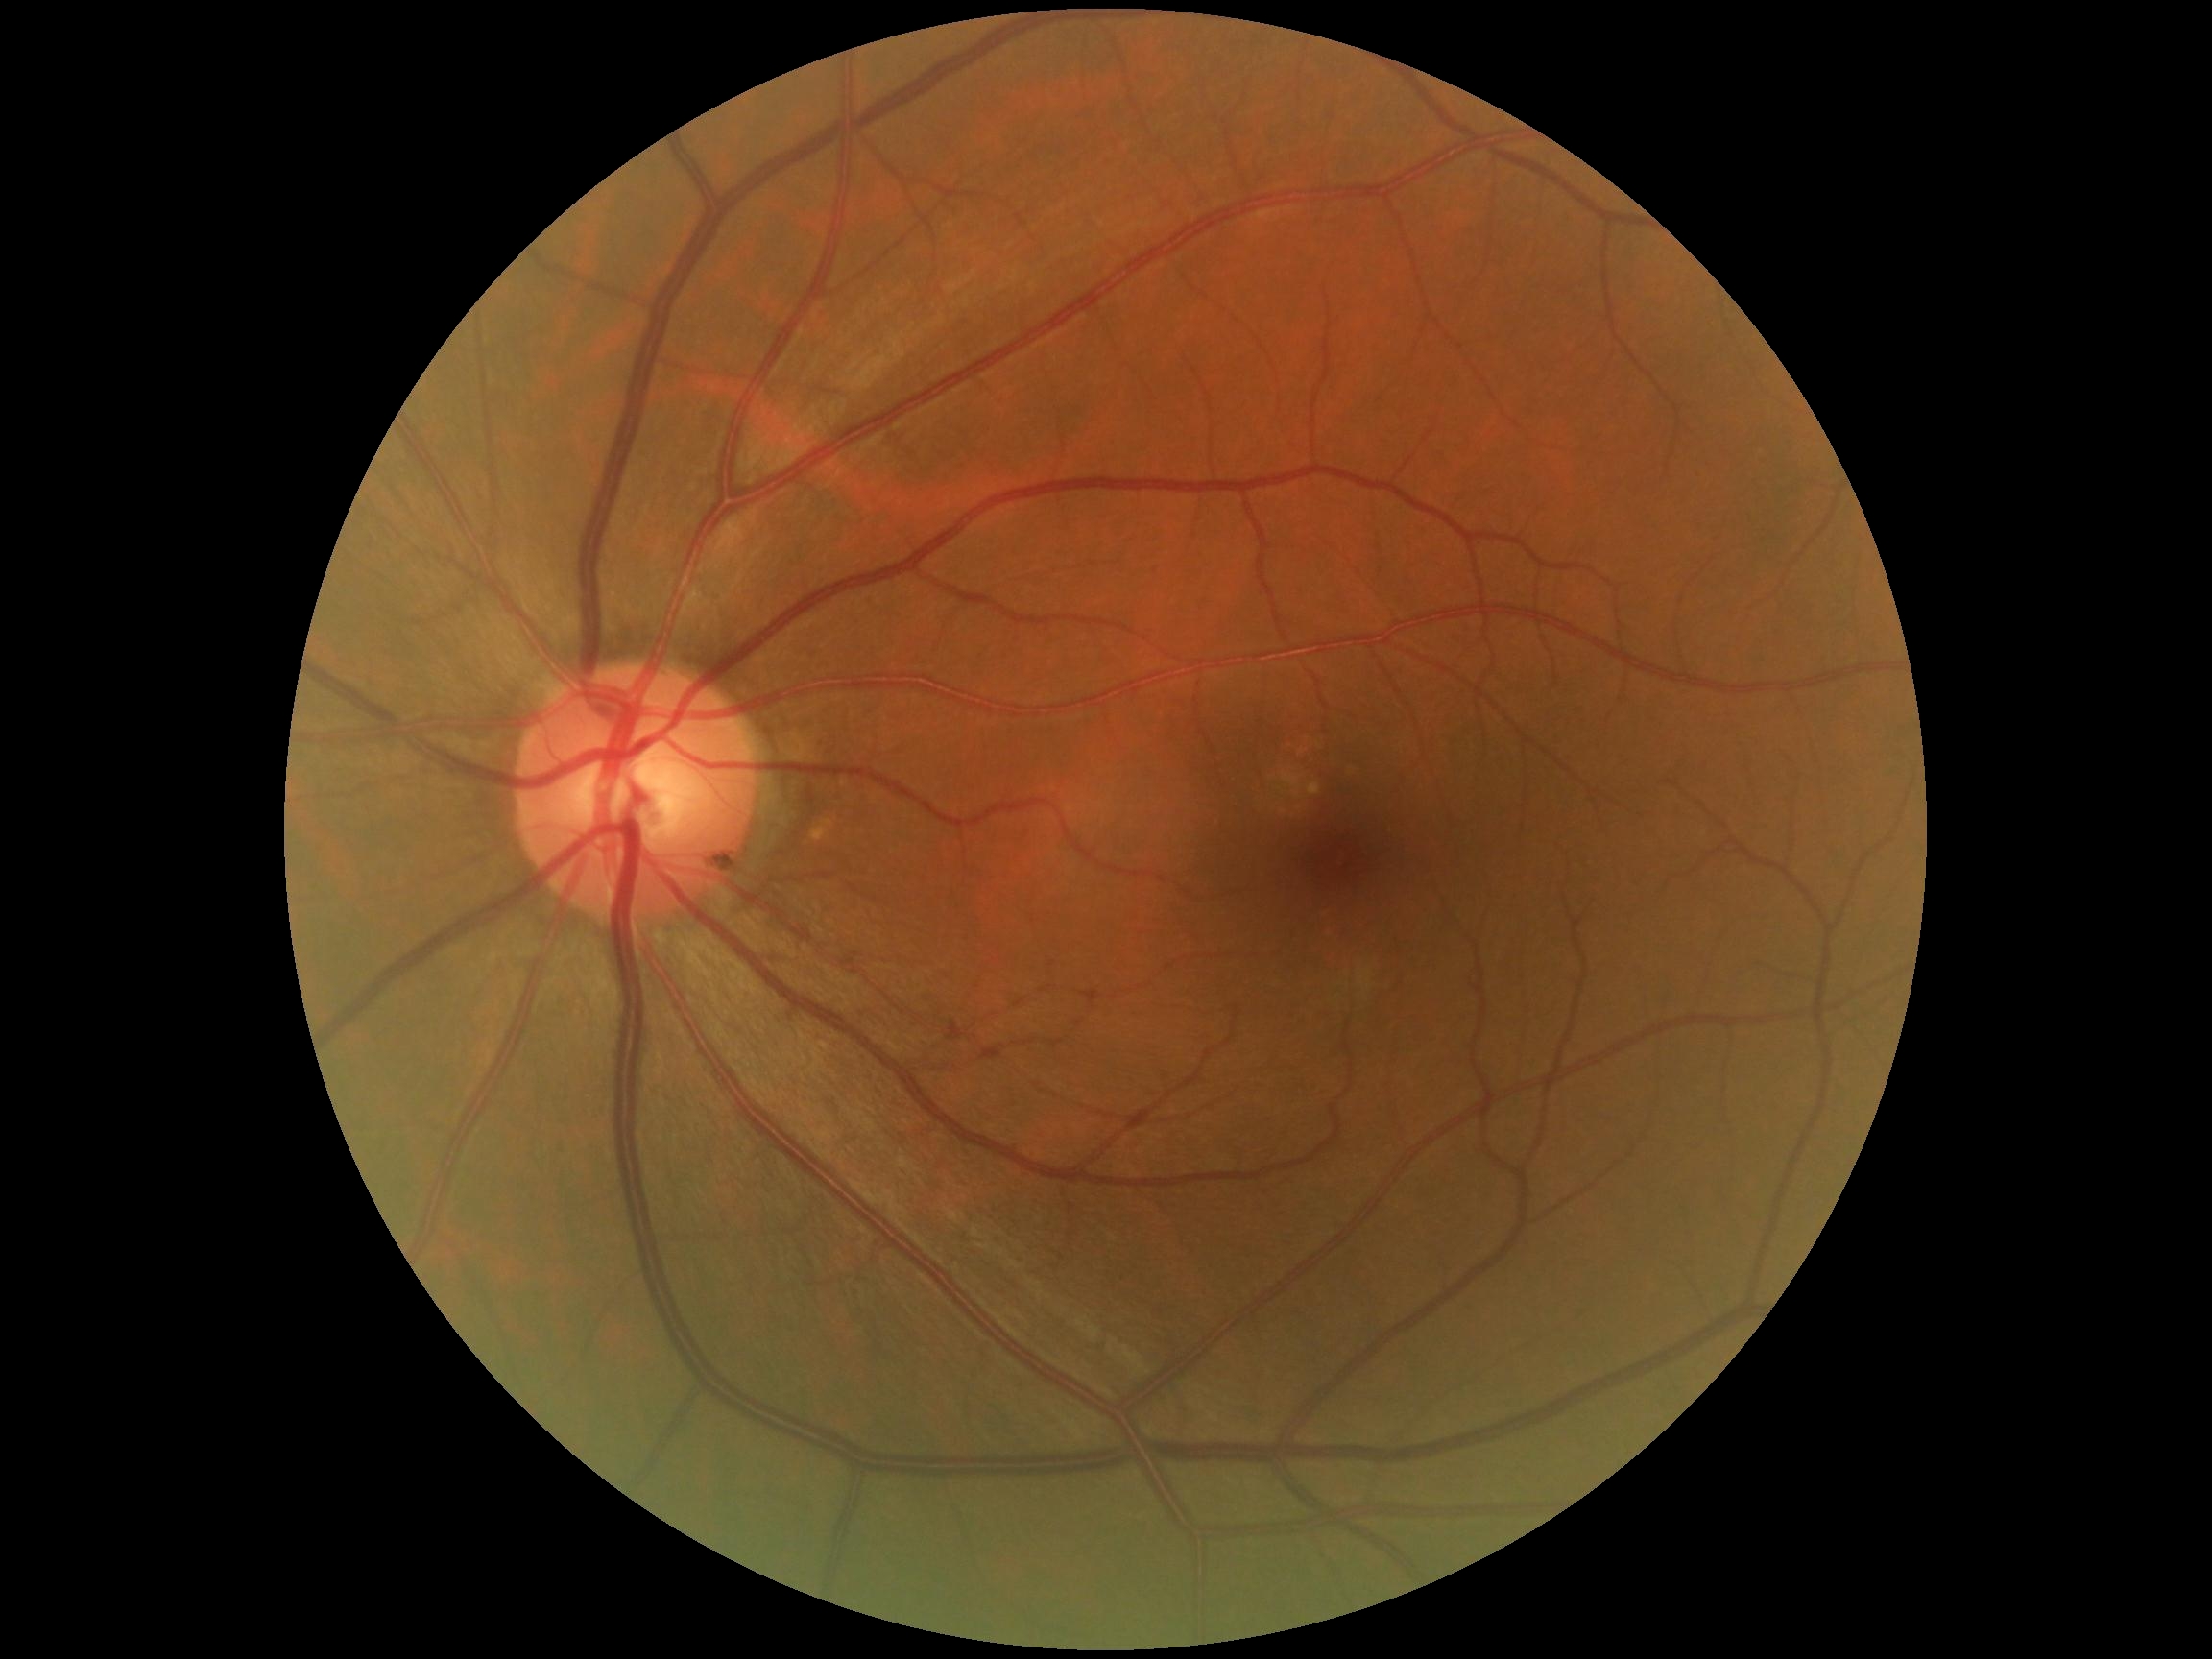
dr_grade: grade 0